Wide-field fundus image from infant ROP screening; 1240x1240; 100° field of view (Phoenix ICON) — 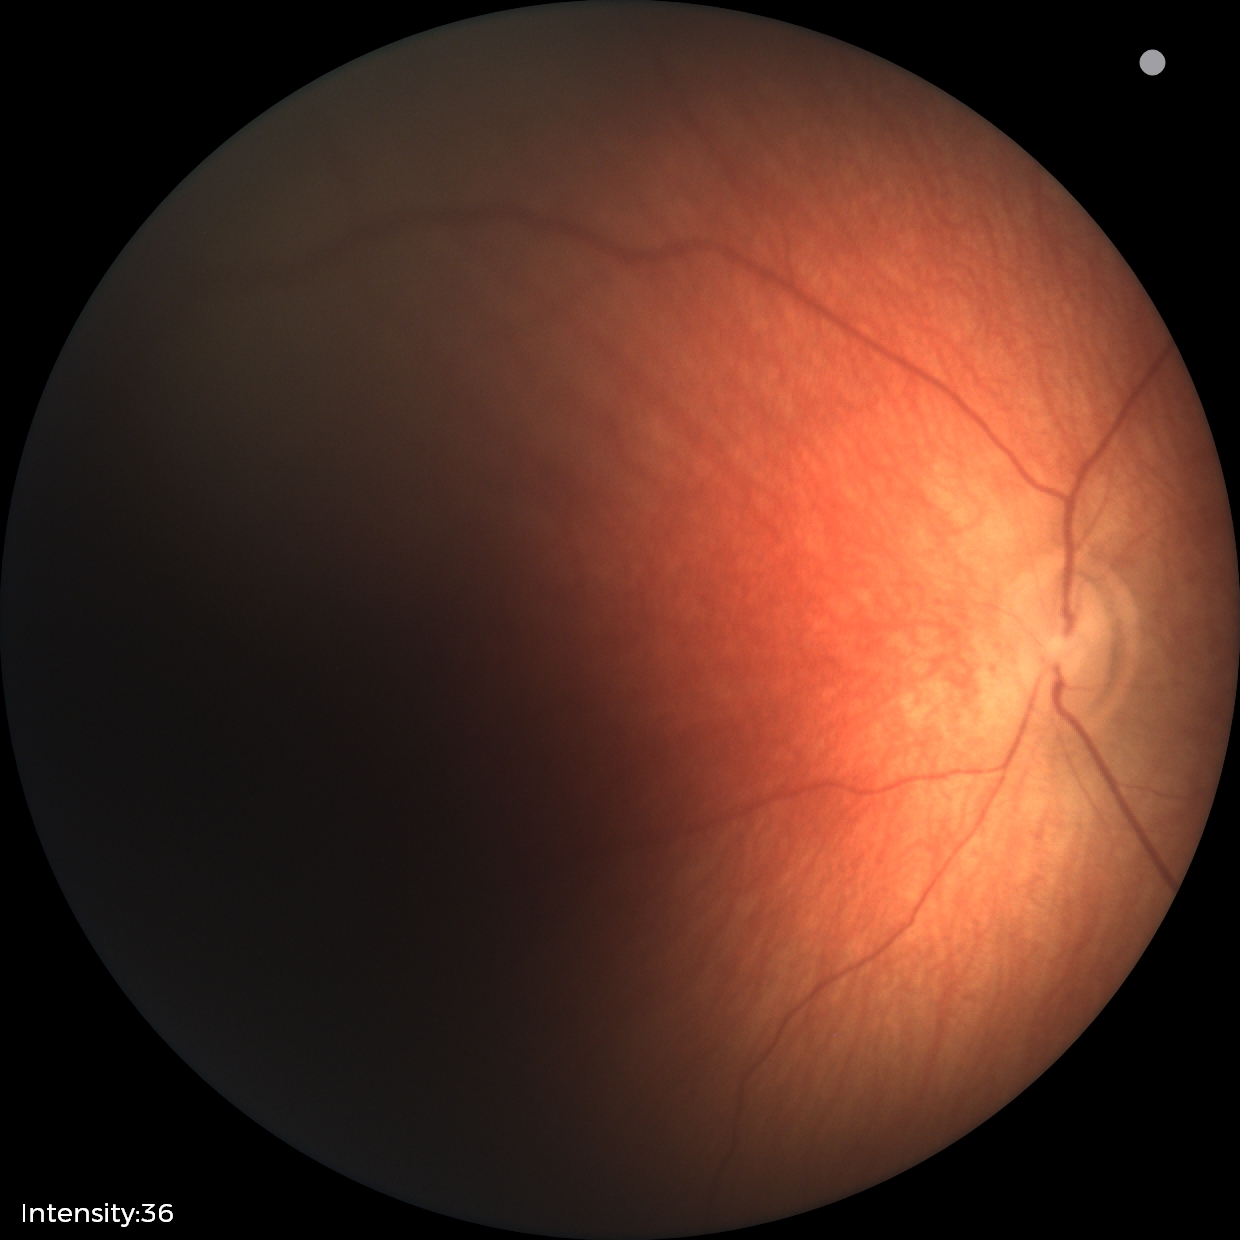

Normal screening examination.